Color fundus image; 45° FOV
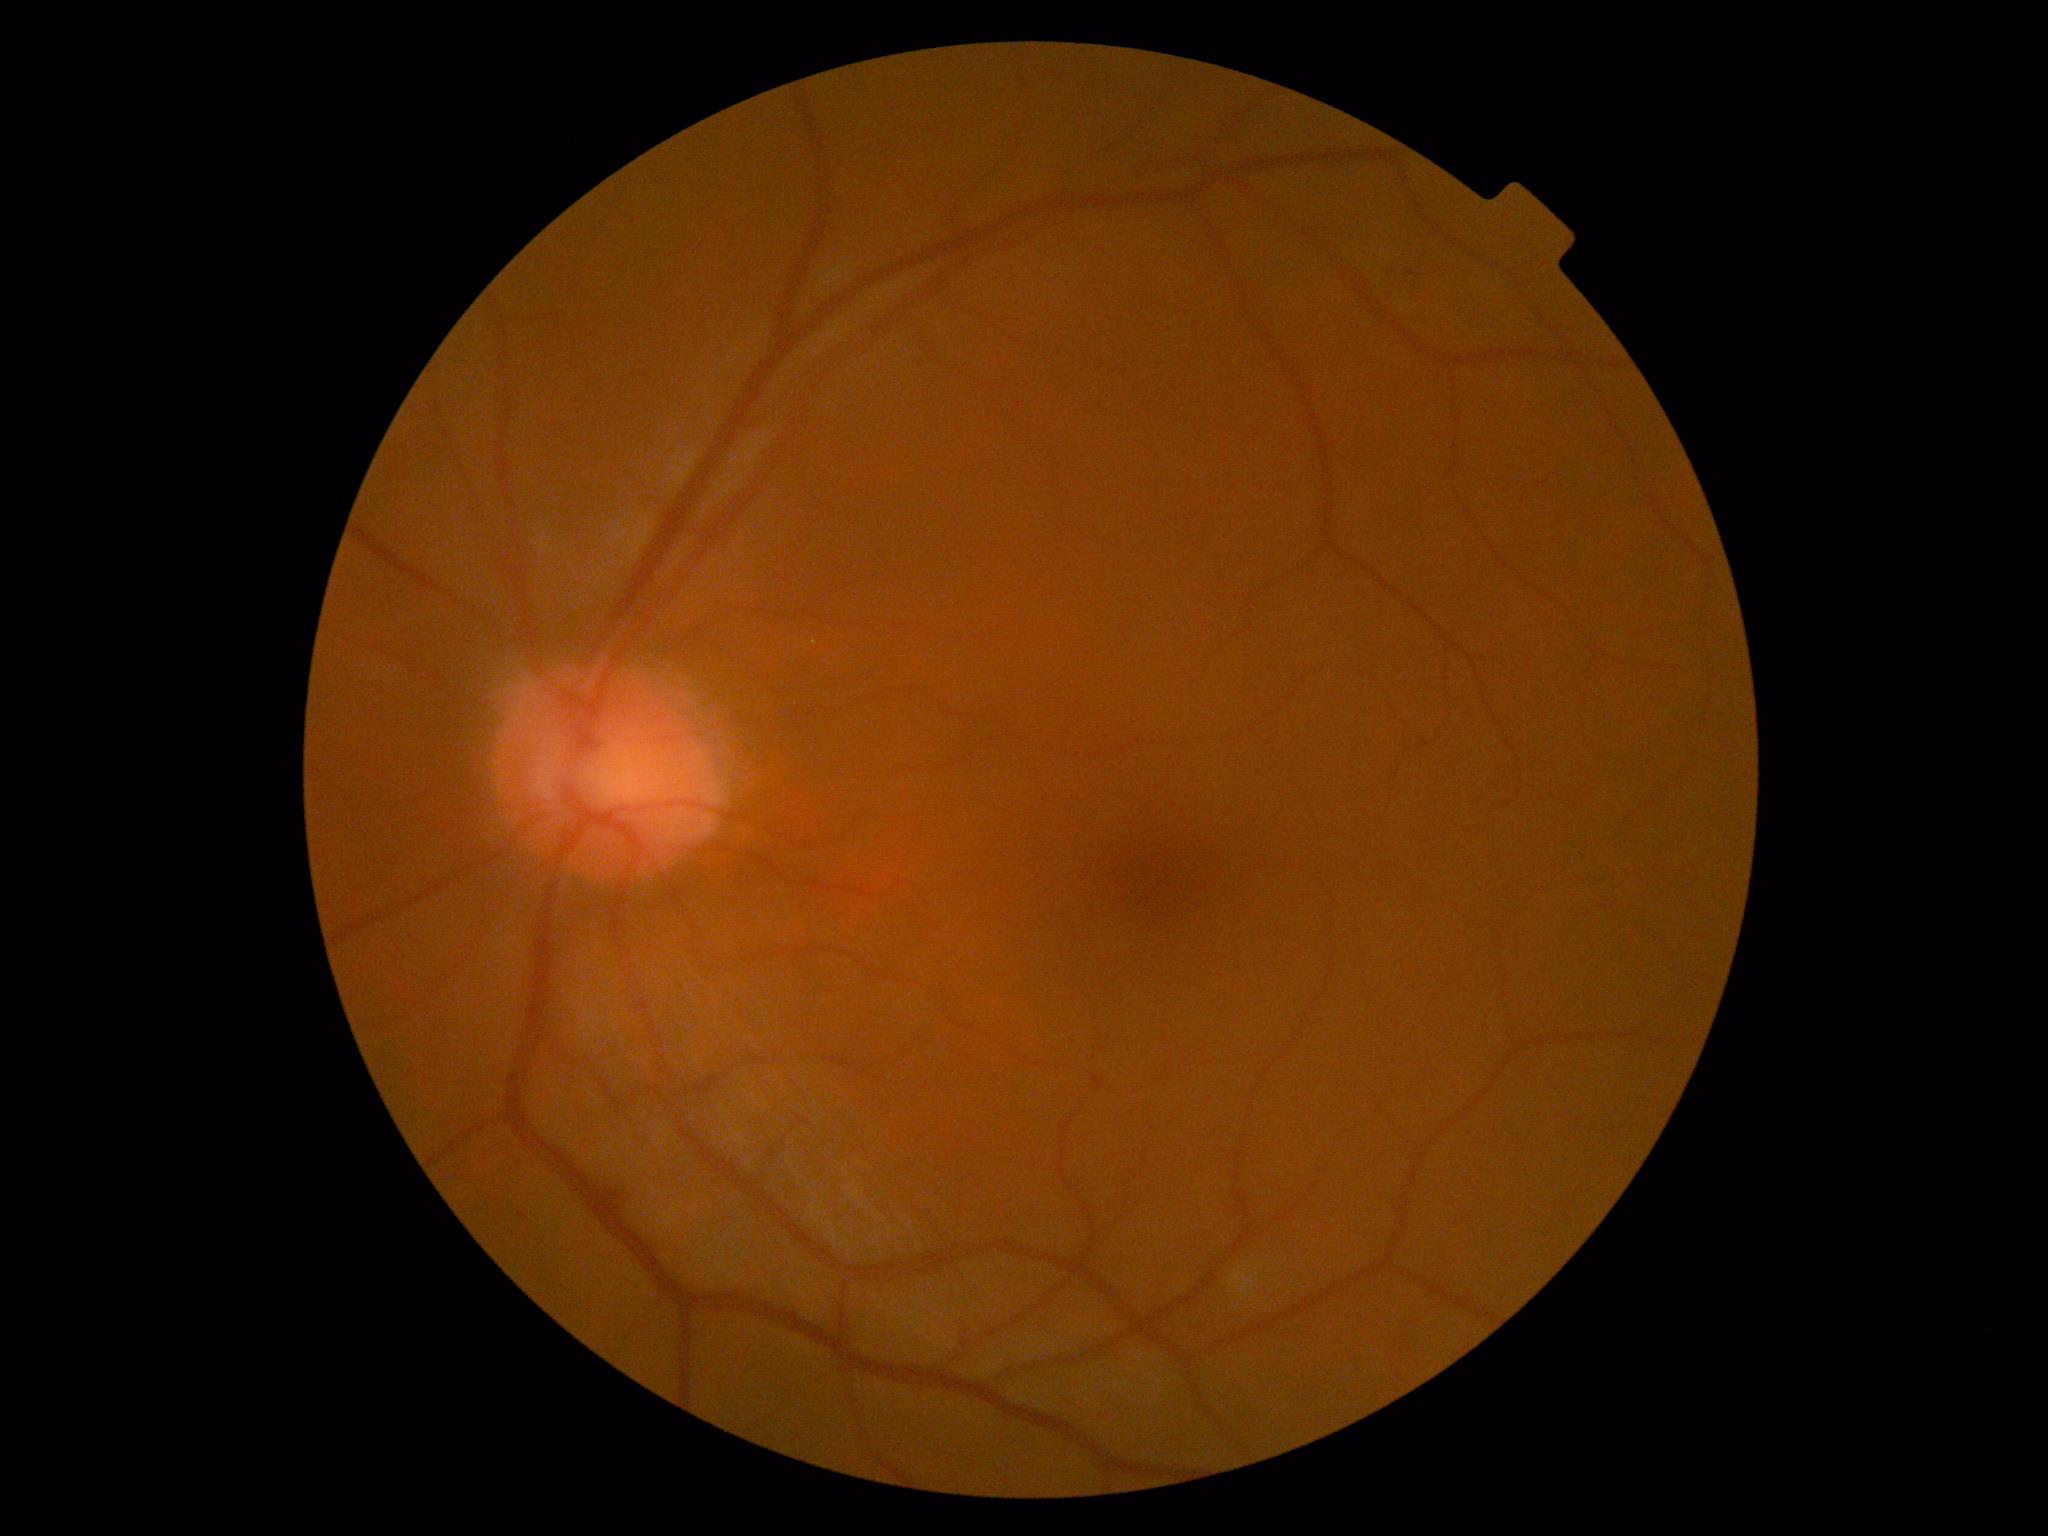

DR stage: 2/4